Image size 848x848; color fundus photograph; modified Davis classification; NIDEK AFC-230 fundus camera: 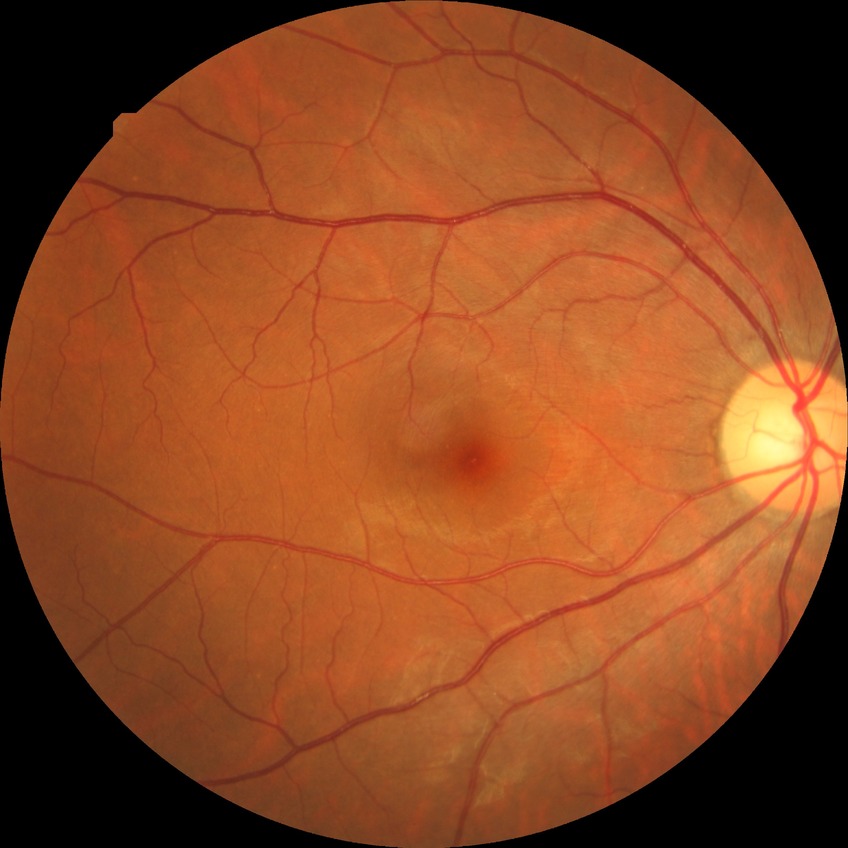
retinopathy grade: no diabetic retinopathy.